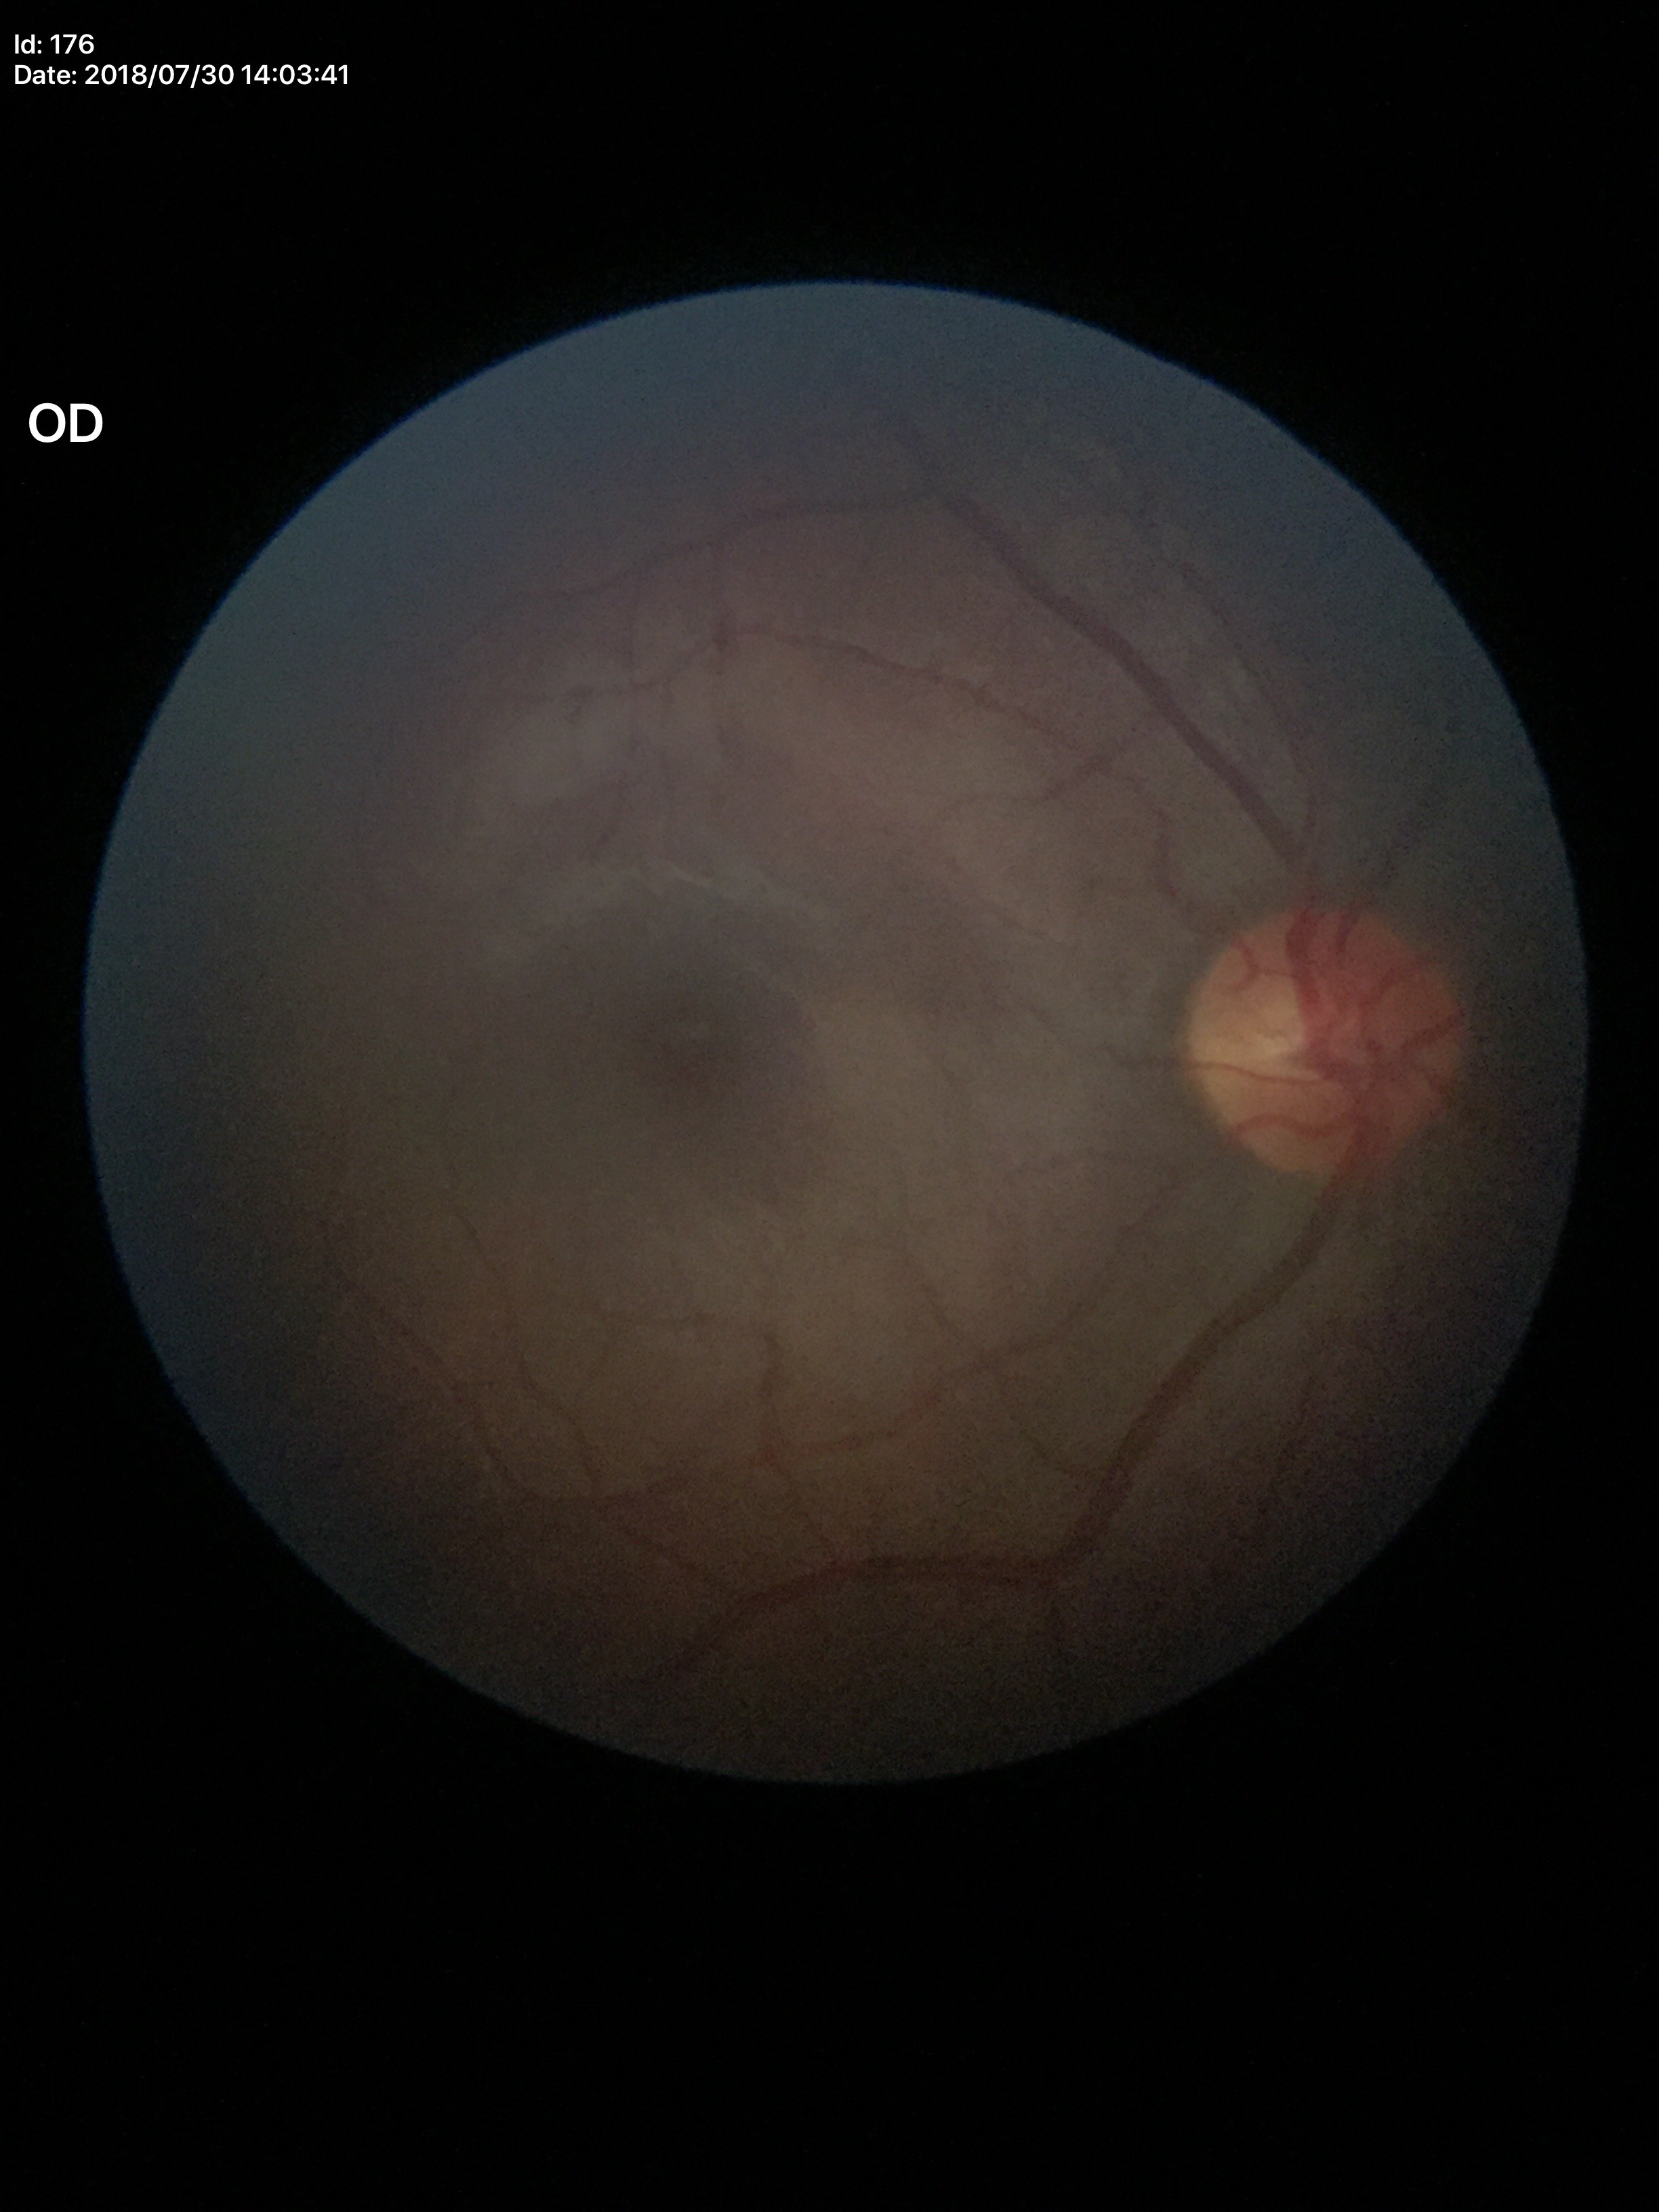

Glaucoma evaluation: negative (1/5 graders called glaucoma suspect).
Vertical cup-disc ratio (VCDR) is 0.53.